848x848, color fundus image, acquired with a NIDEK AFC-230, 45-degree field of view, nonmydriatic fundus photograph
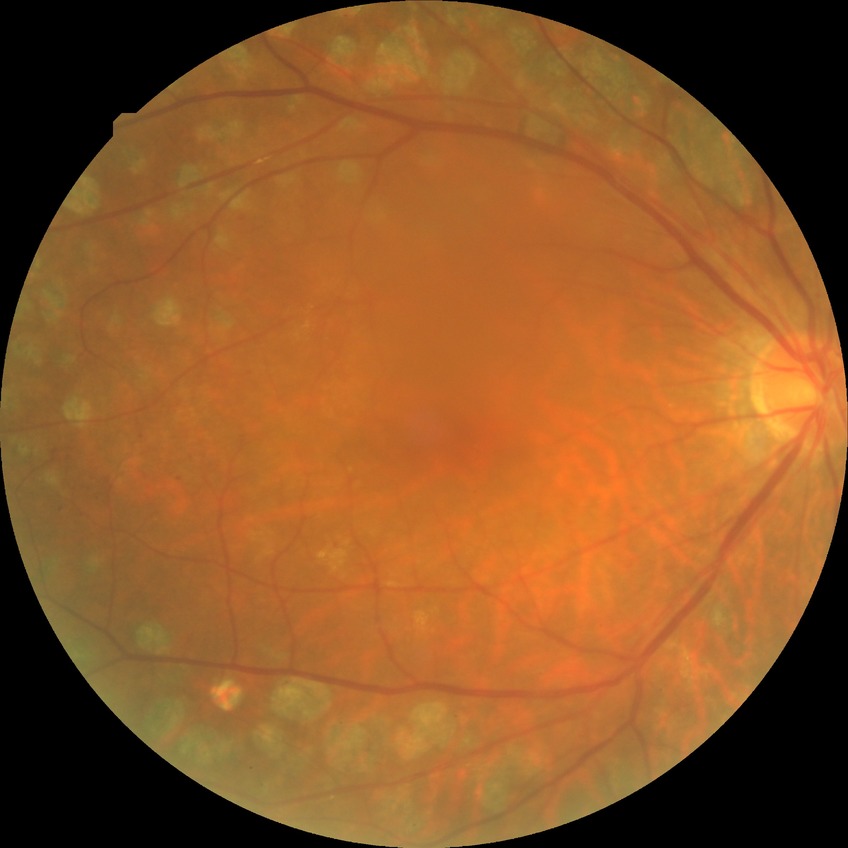

diabetic retinopathy (DR): PDR (proliferative diabetic retinopathy).